Acquired with a Nidek AFC-330 — 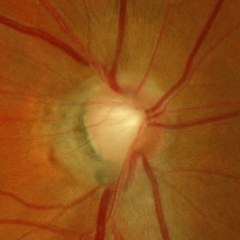

Q: Is glaucoma present?
A: Yes — early glaucoma. Diagnostic criteria: glaucomatous retinal nerve fiber layer defects on red-free fundus photography without visual field defects.